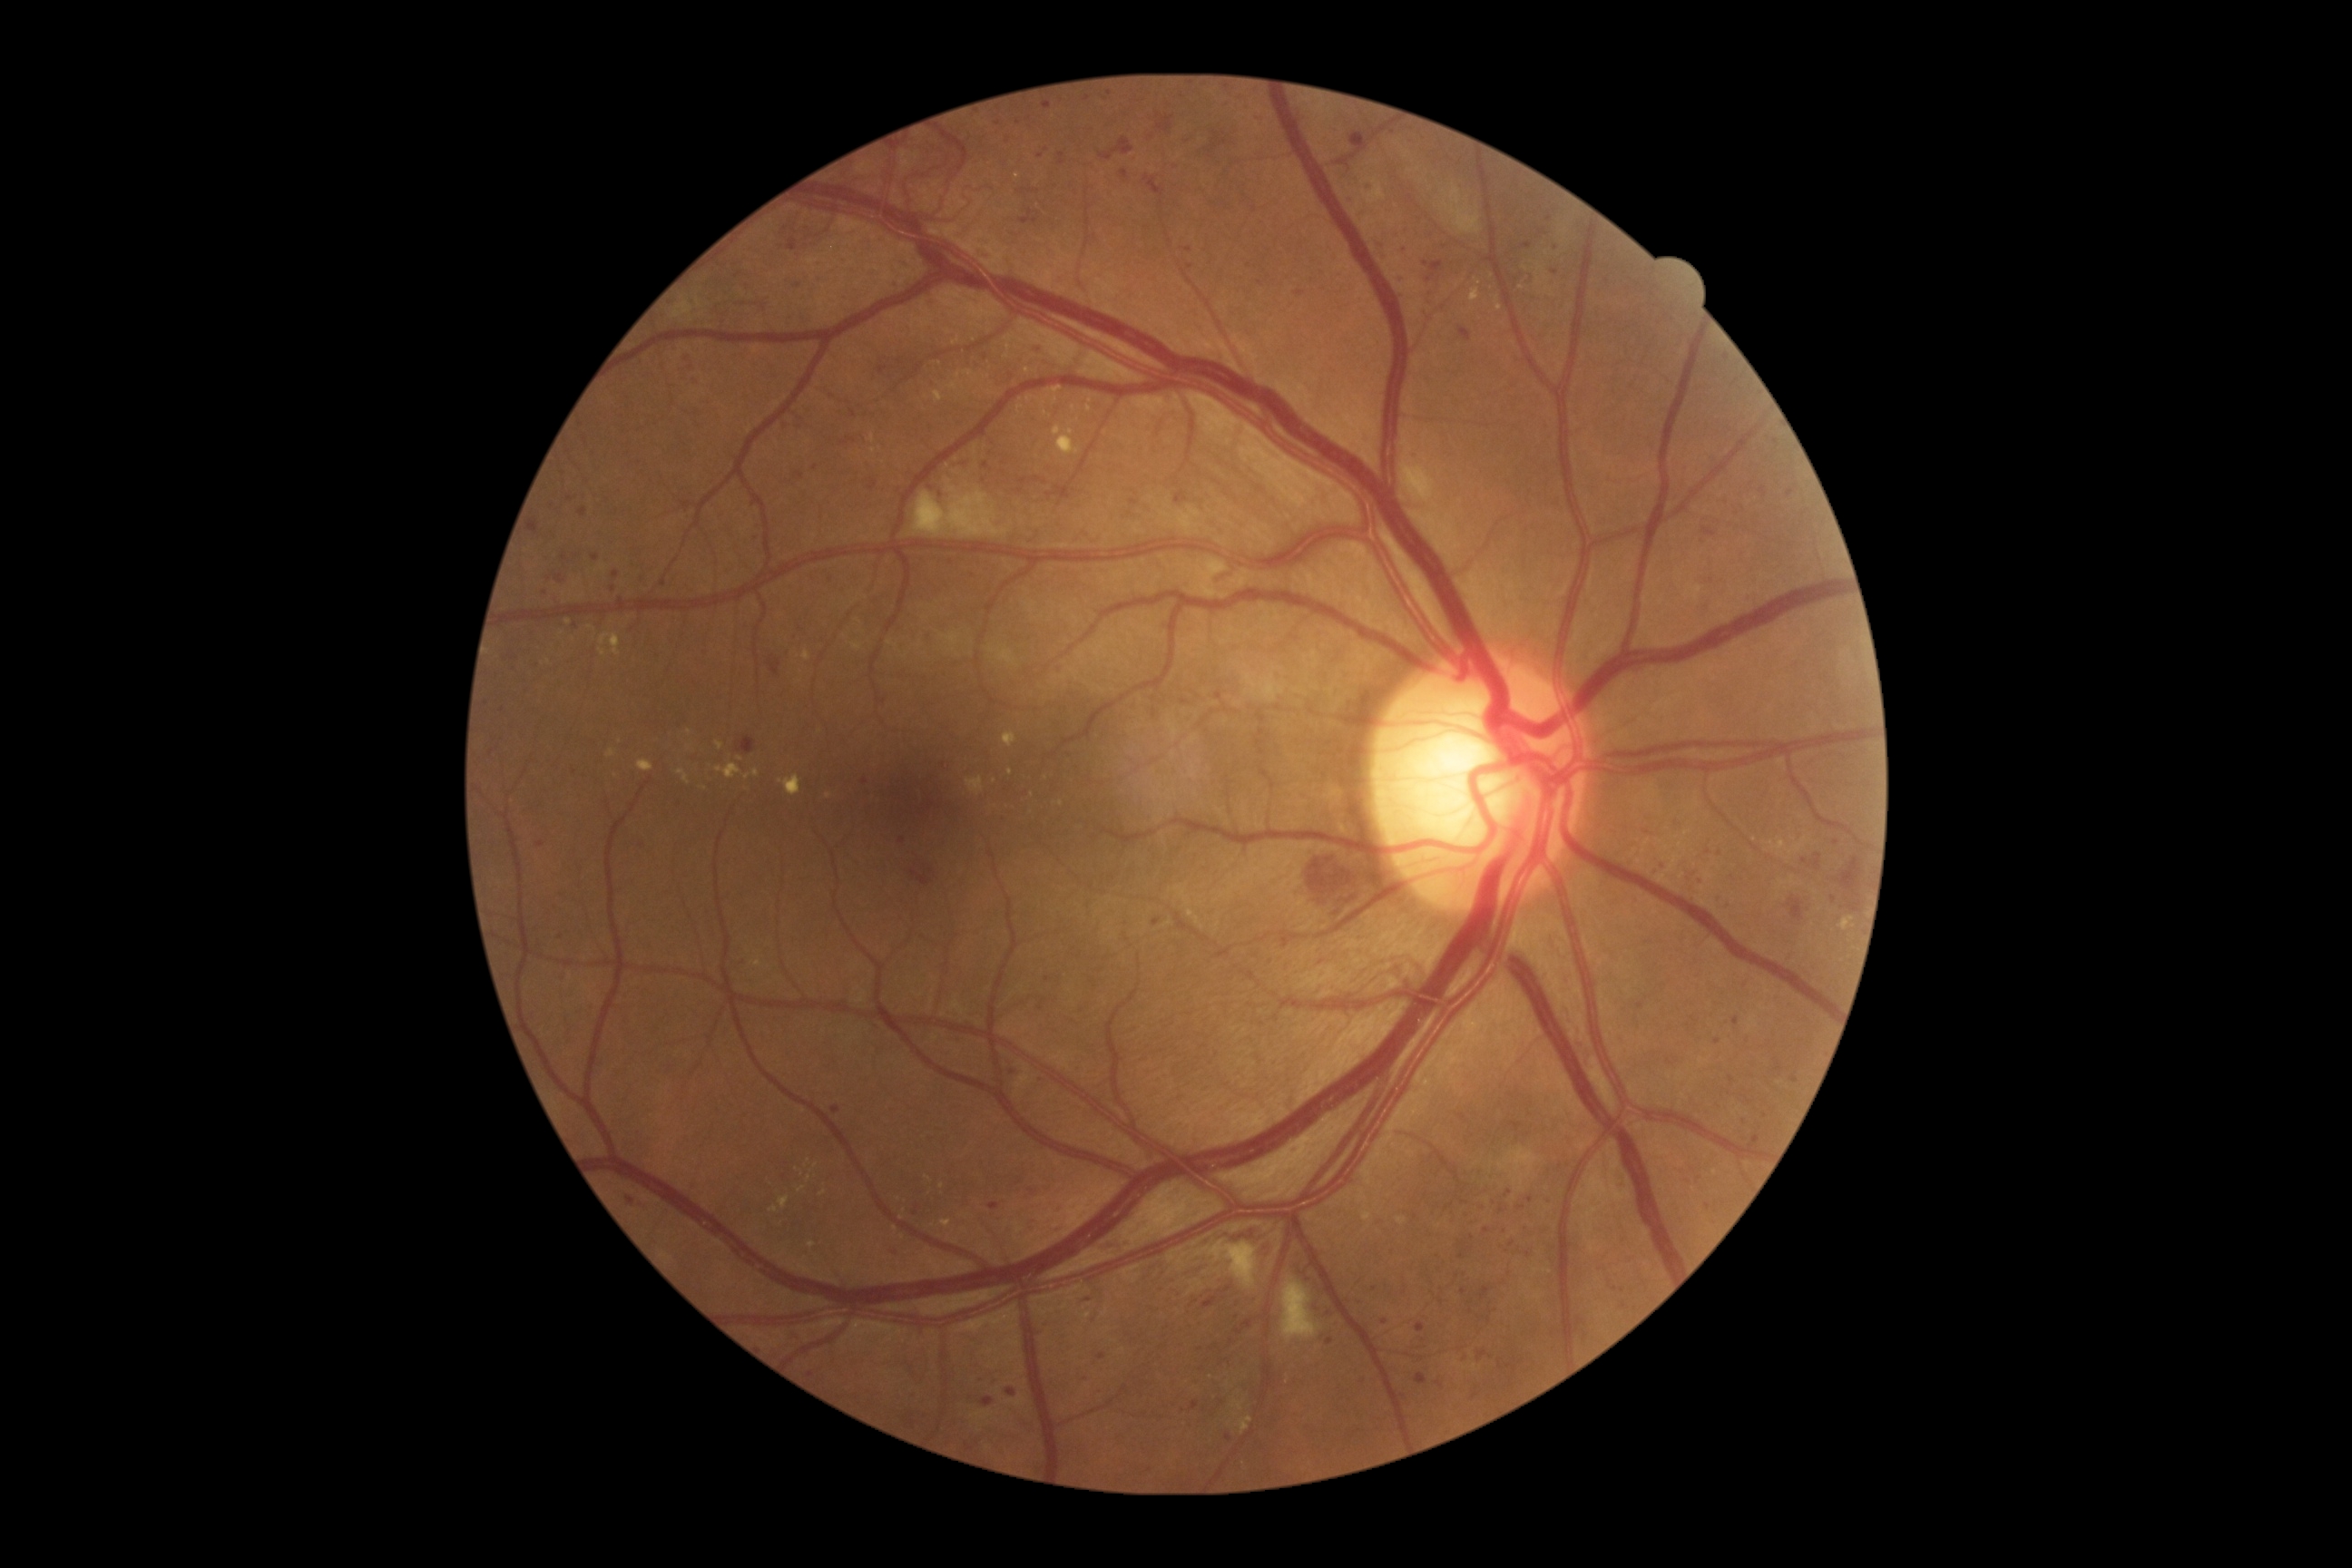 Diabetic retinopathy (DR) is grade 3.
Microaneurysms (MAs) are present, including at x1=504, y1=651, x2=514, y2=663 | x1=1367, y1=184, x2=1375, y2=193 | x1=841, y1=436, x2=856, y2=446 | x1=1295, y1=291, x2=1304, y2=297 | x1=1752, y1=1135, x2=1758, y2=1148 | x1=796, y1=471, x2=805, y2=480 | x1=1696, y1=879, x2=1707, y2=885 | x1=1242, y1=1320, x2=1253, y2=1329.
Small MAs near 1012/376 | 1624/1306 | 631/1201 | 1047/980 | 1503/1209 | 811/1375 | 1776/443 | 1462/1257 | 1329/1343 | 902/840 | 1616/1289.